Color fundus image · 240x240px · captured on a Nidek AFC-330 fundus camera.
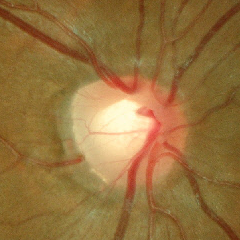
There is evidence of no glaucomatous optic neuropathy.